ONH-centered crop from a color fundus image:
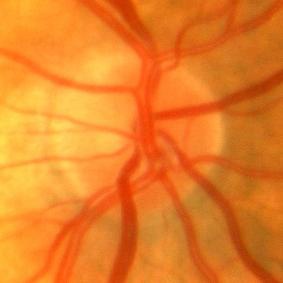 Demonstrates no glaucomatous optic neuropathy.